Wide-field fundus image from infant ROP screening · camera: Clarity RetCam 3 (130° FOV) · 640 x 480 pixels
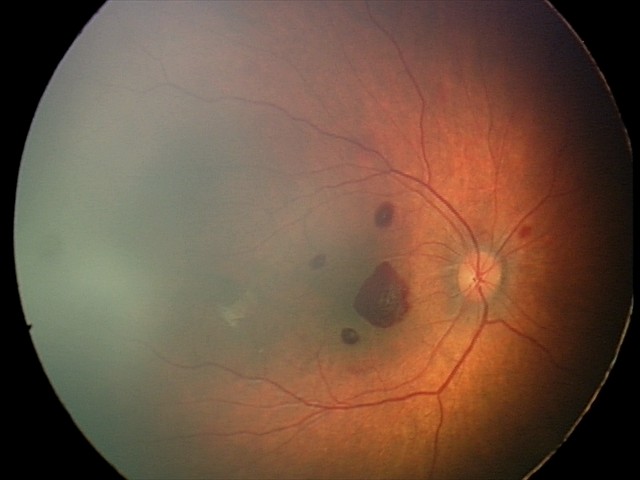 Diagnosis from this screening exam: retinal hemorrhages.